Fundus photo · 45° FOV.
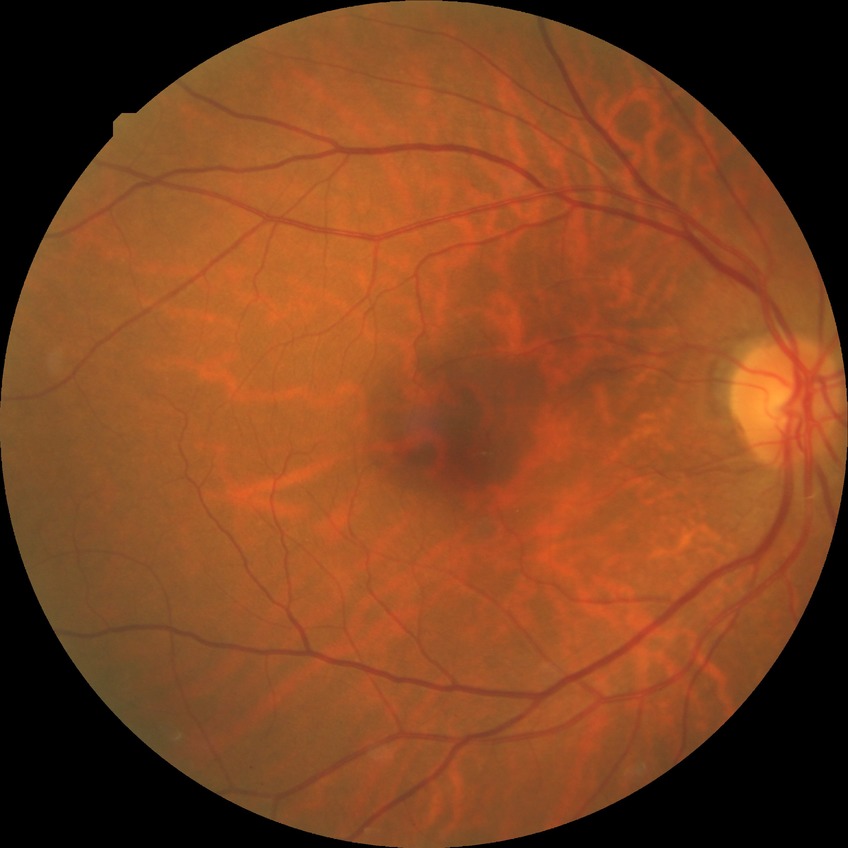 * diabetic retinopathy (DR): no diabetic retinopathy (NDR)